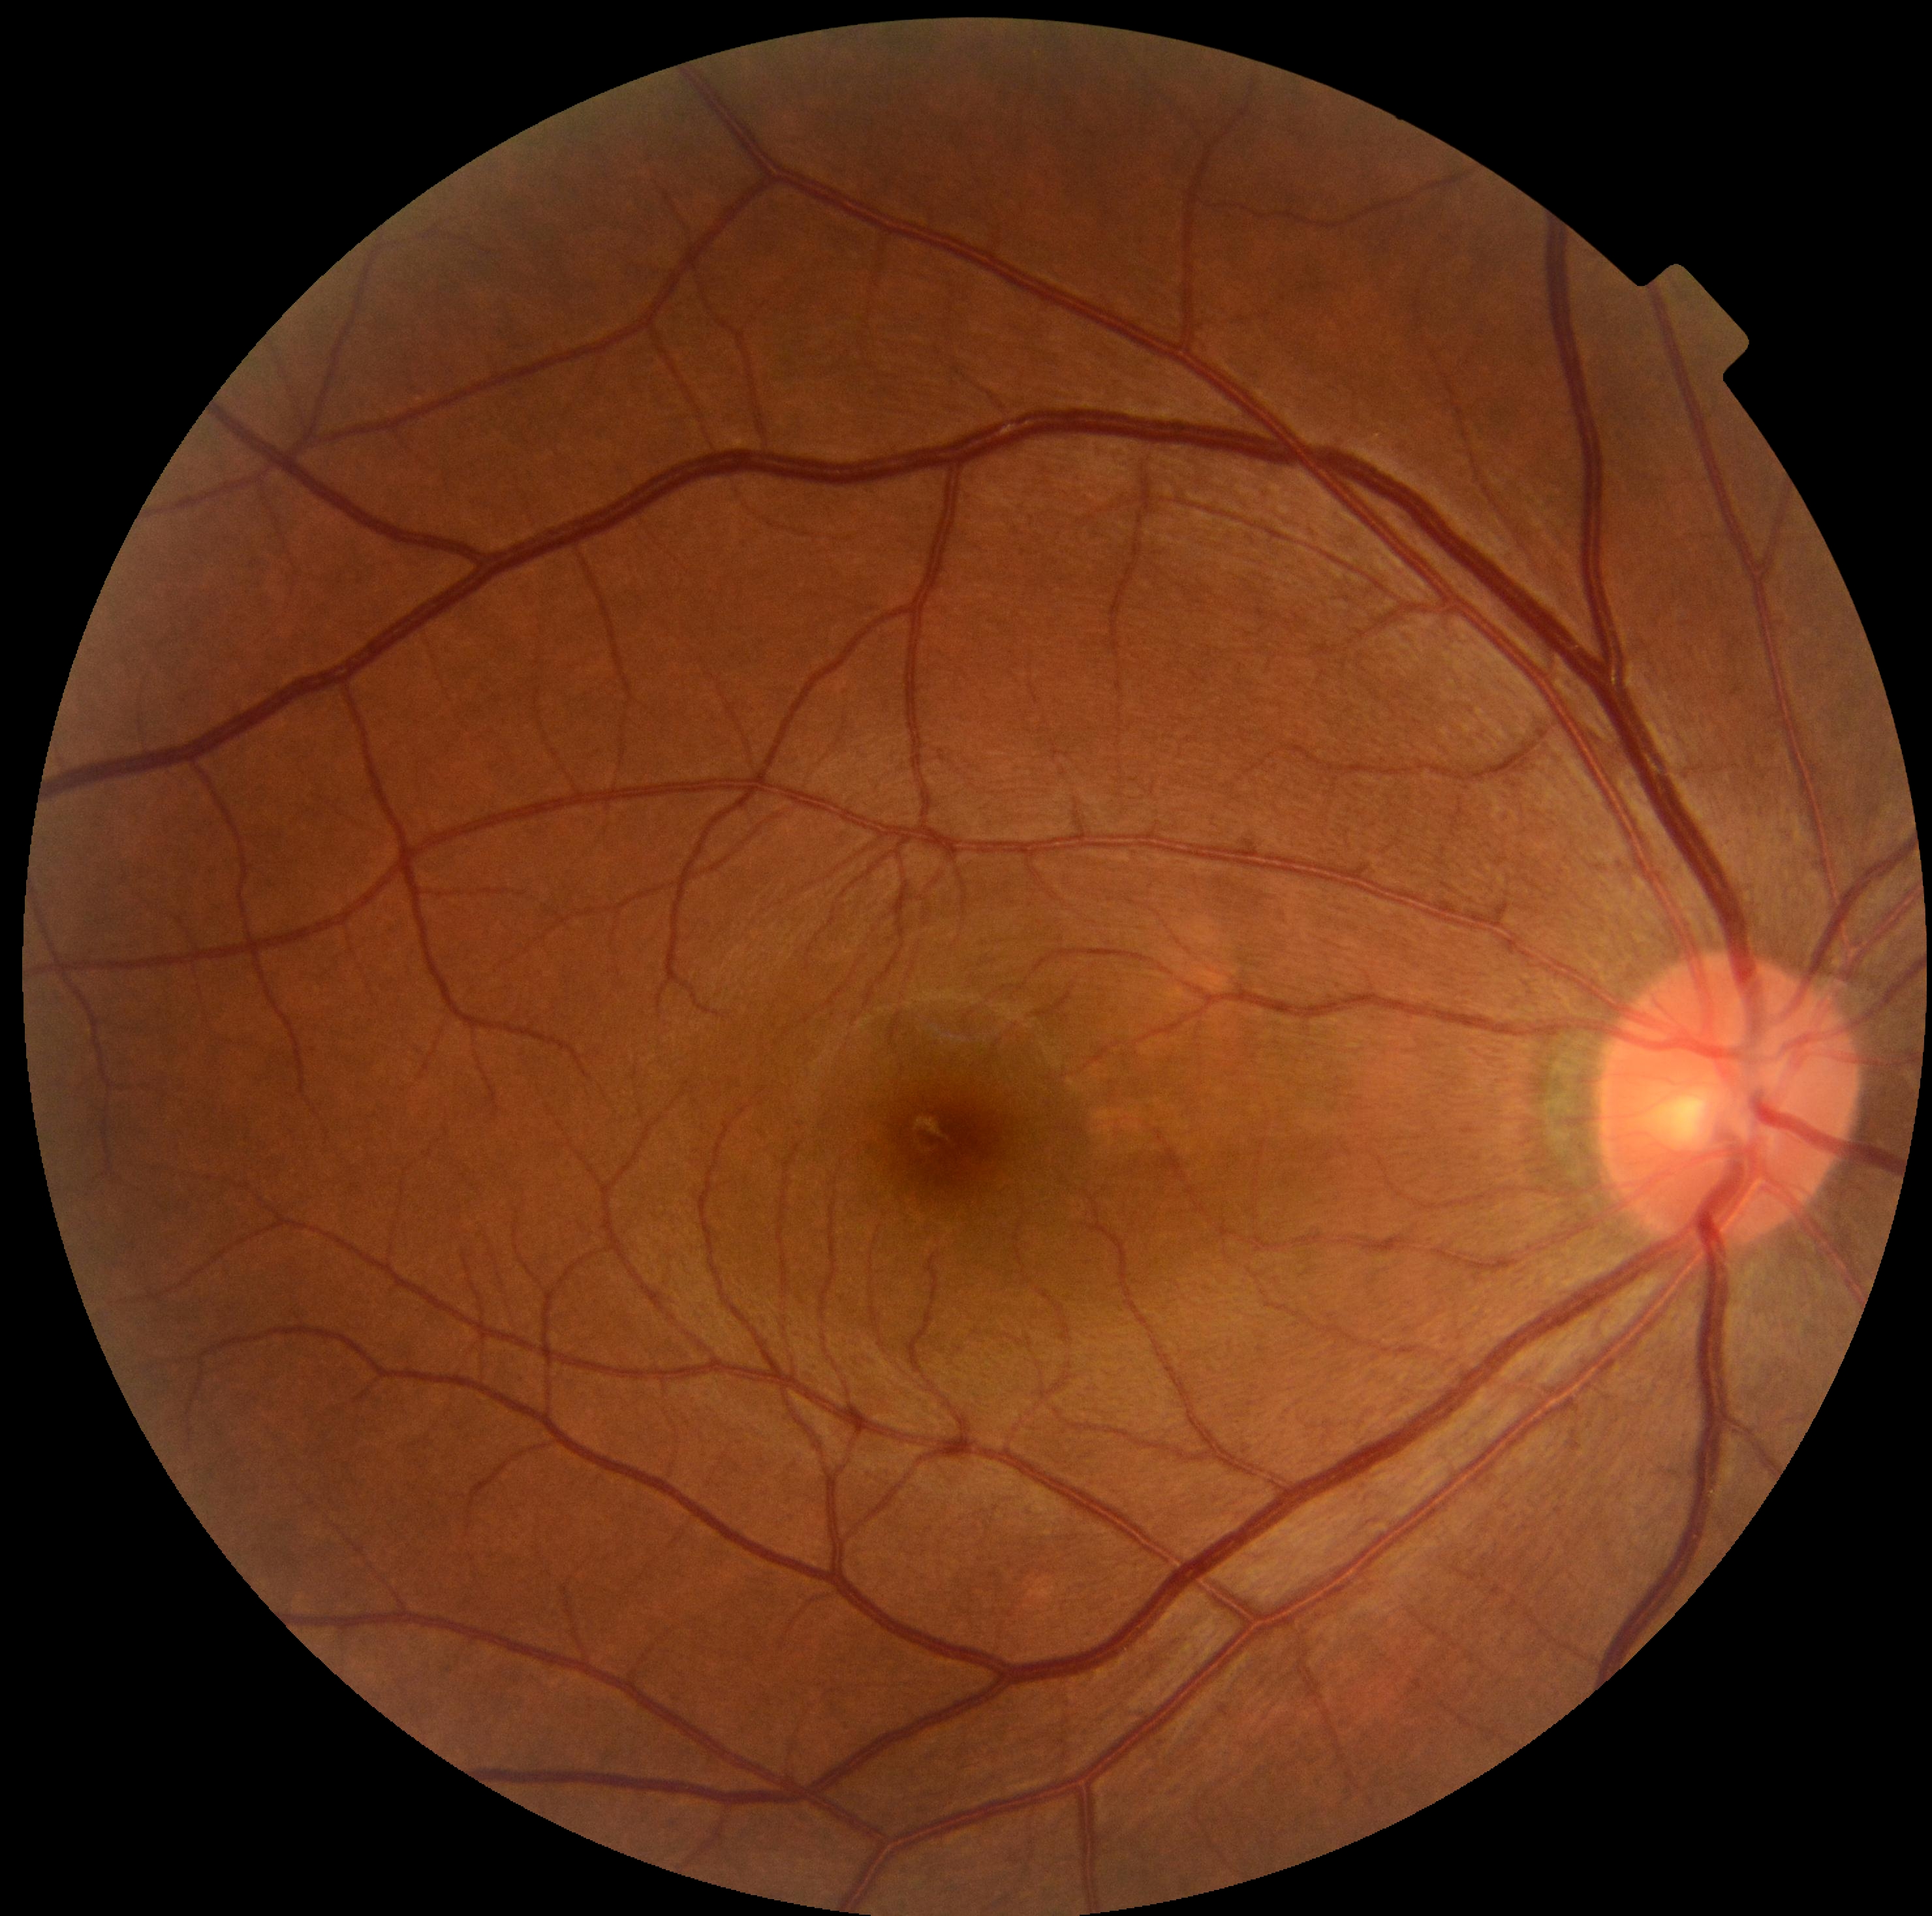

DR: no apparent retinopathy (grade 0); DR impression: no apparent DR.